DR severity per modified Davis staging
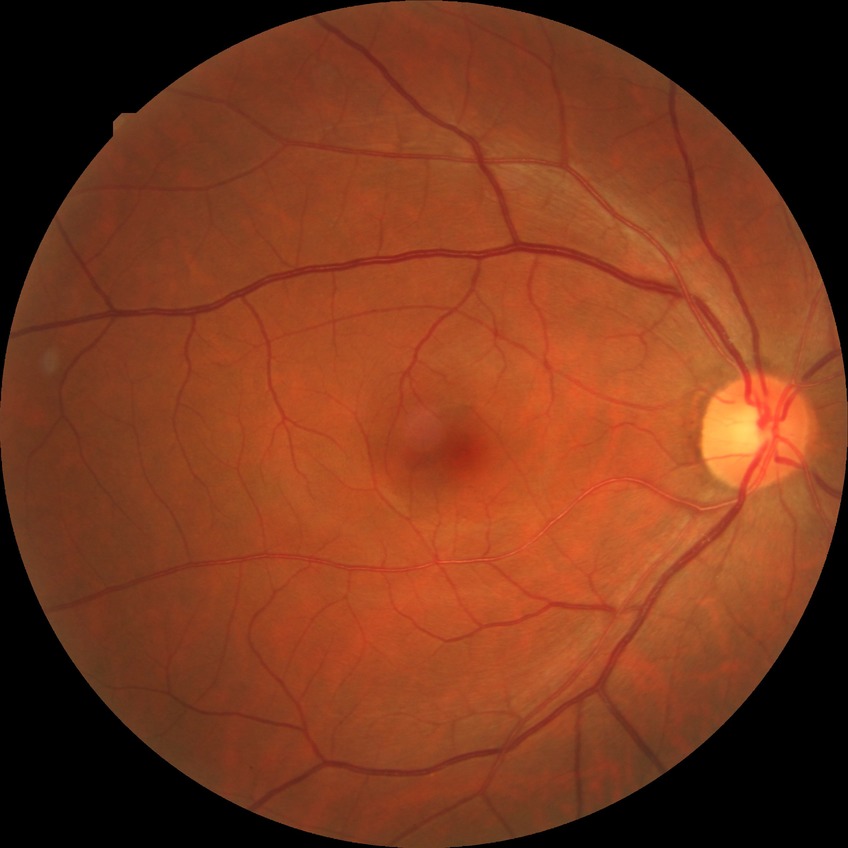 Modified Davis grading is no diabetic retinopathy.